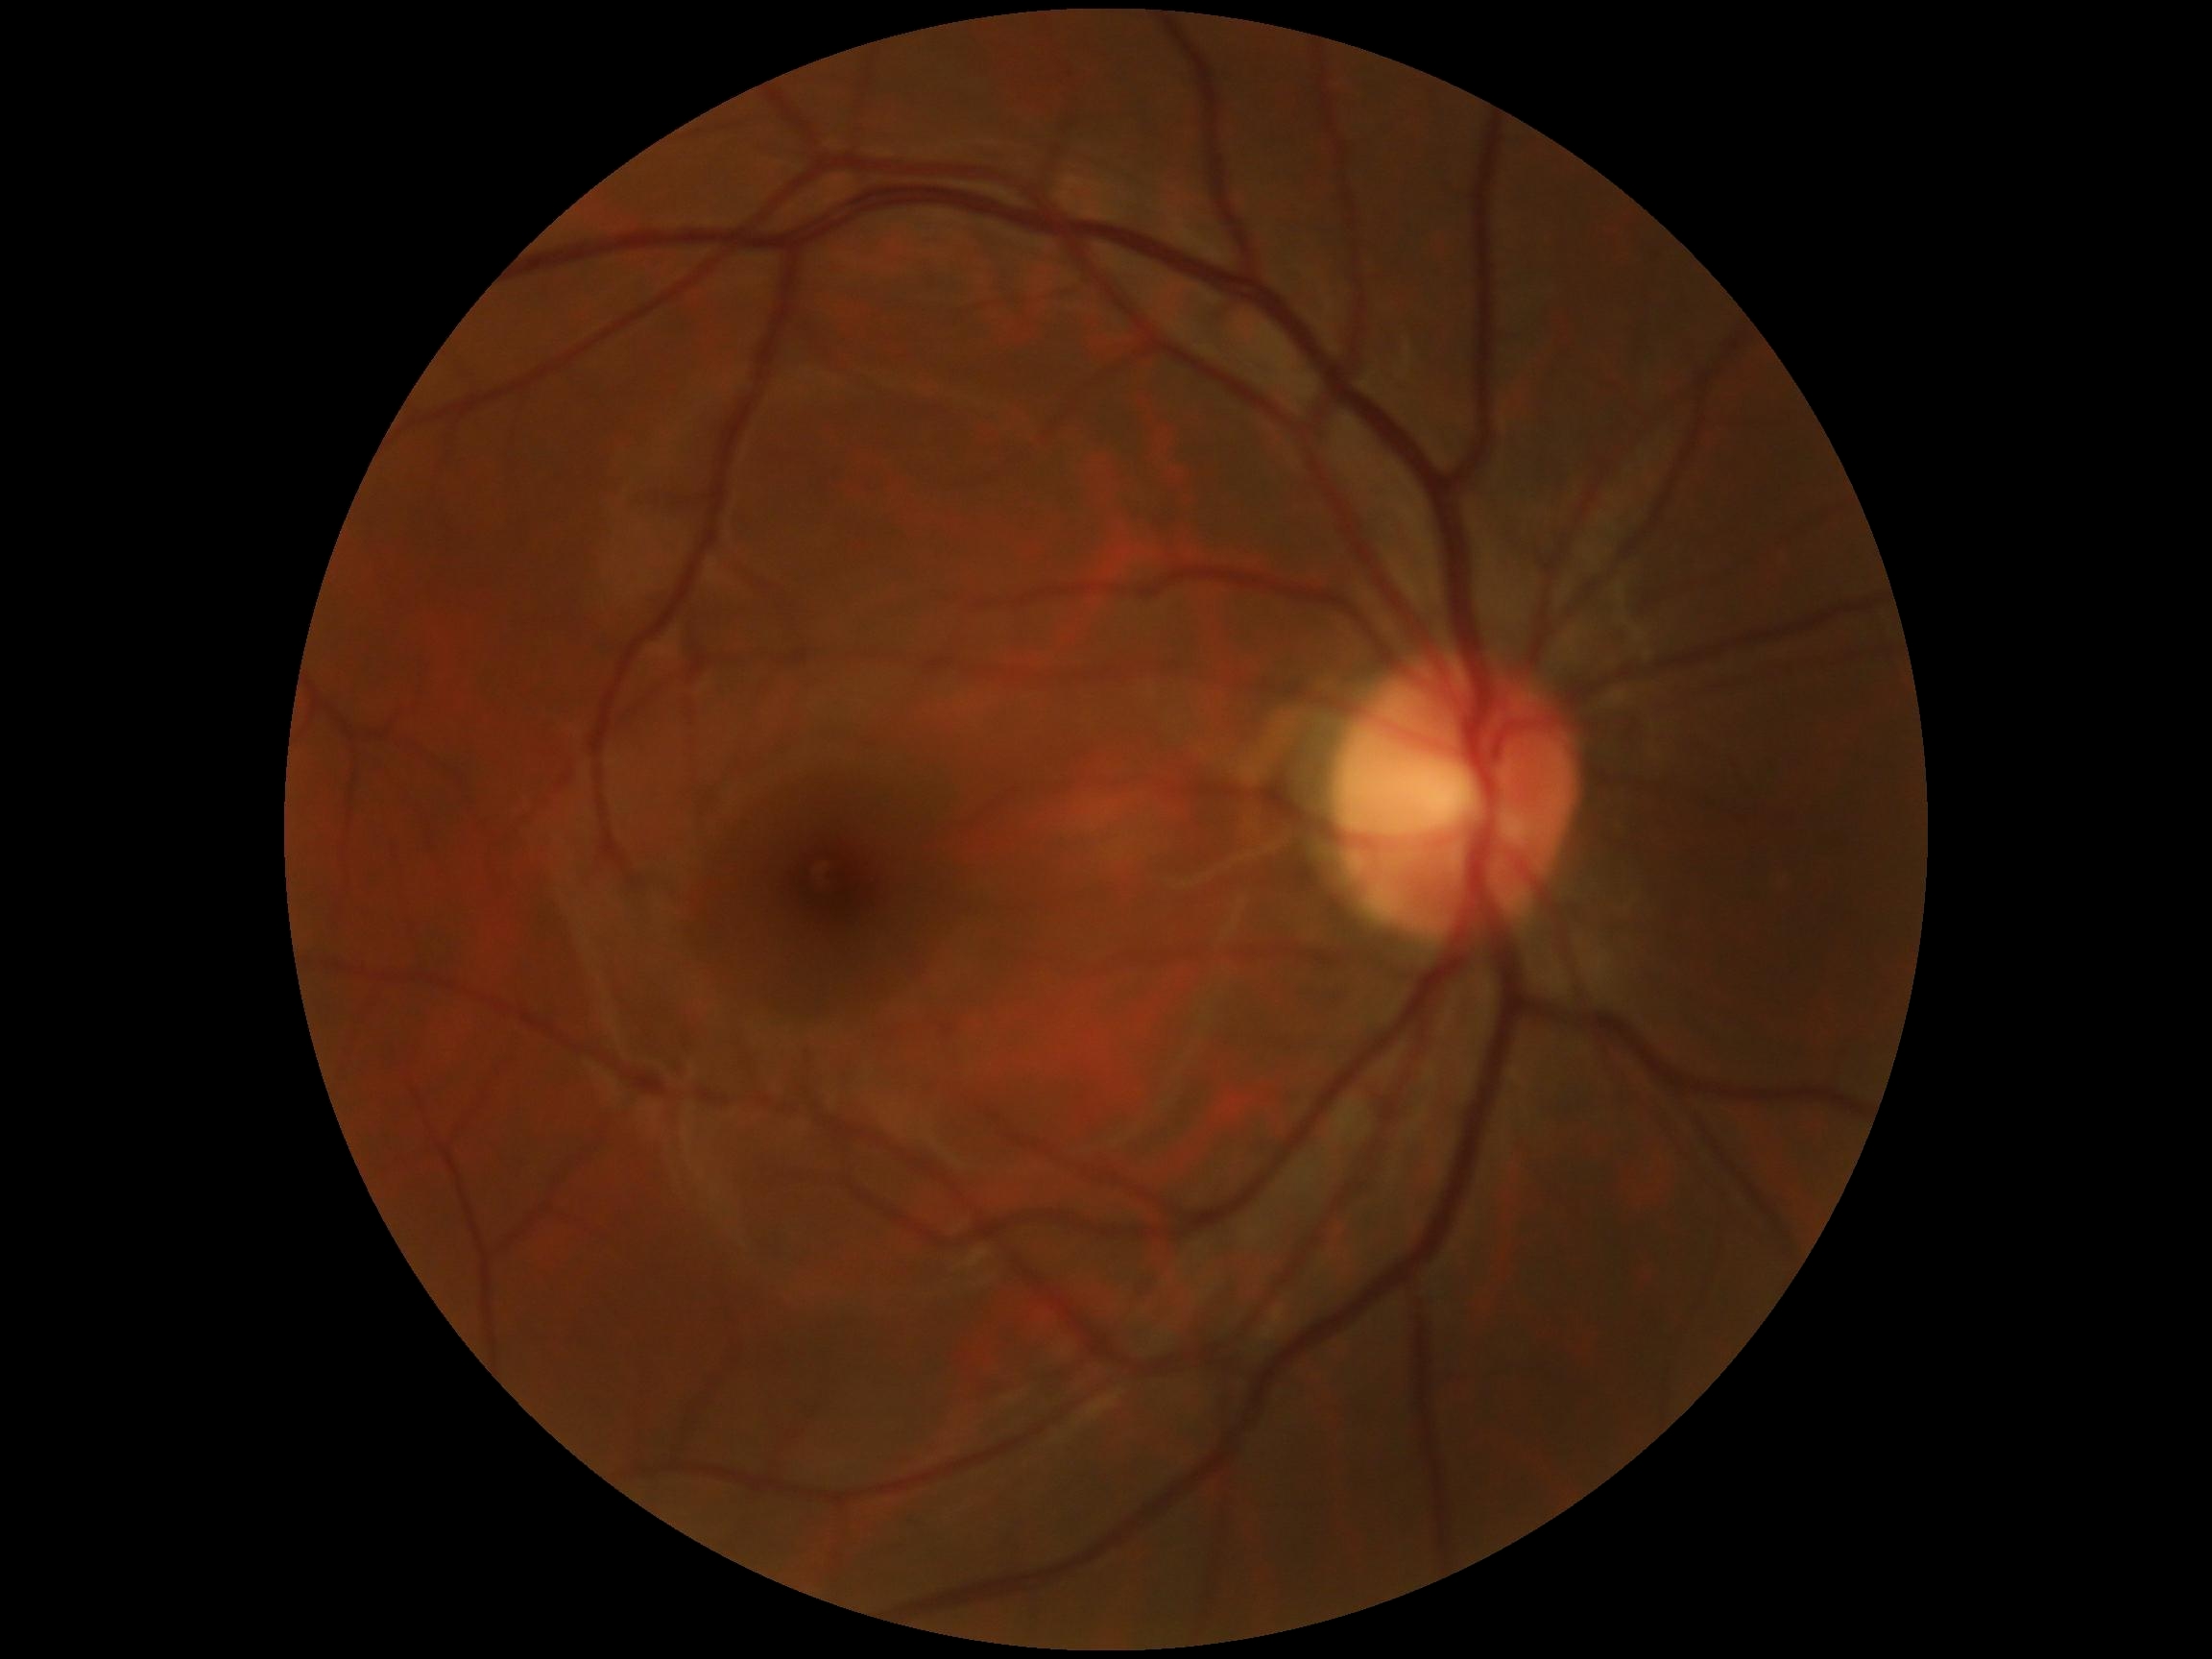

DR: no apparent diabetic retinopathy (grade 0).